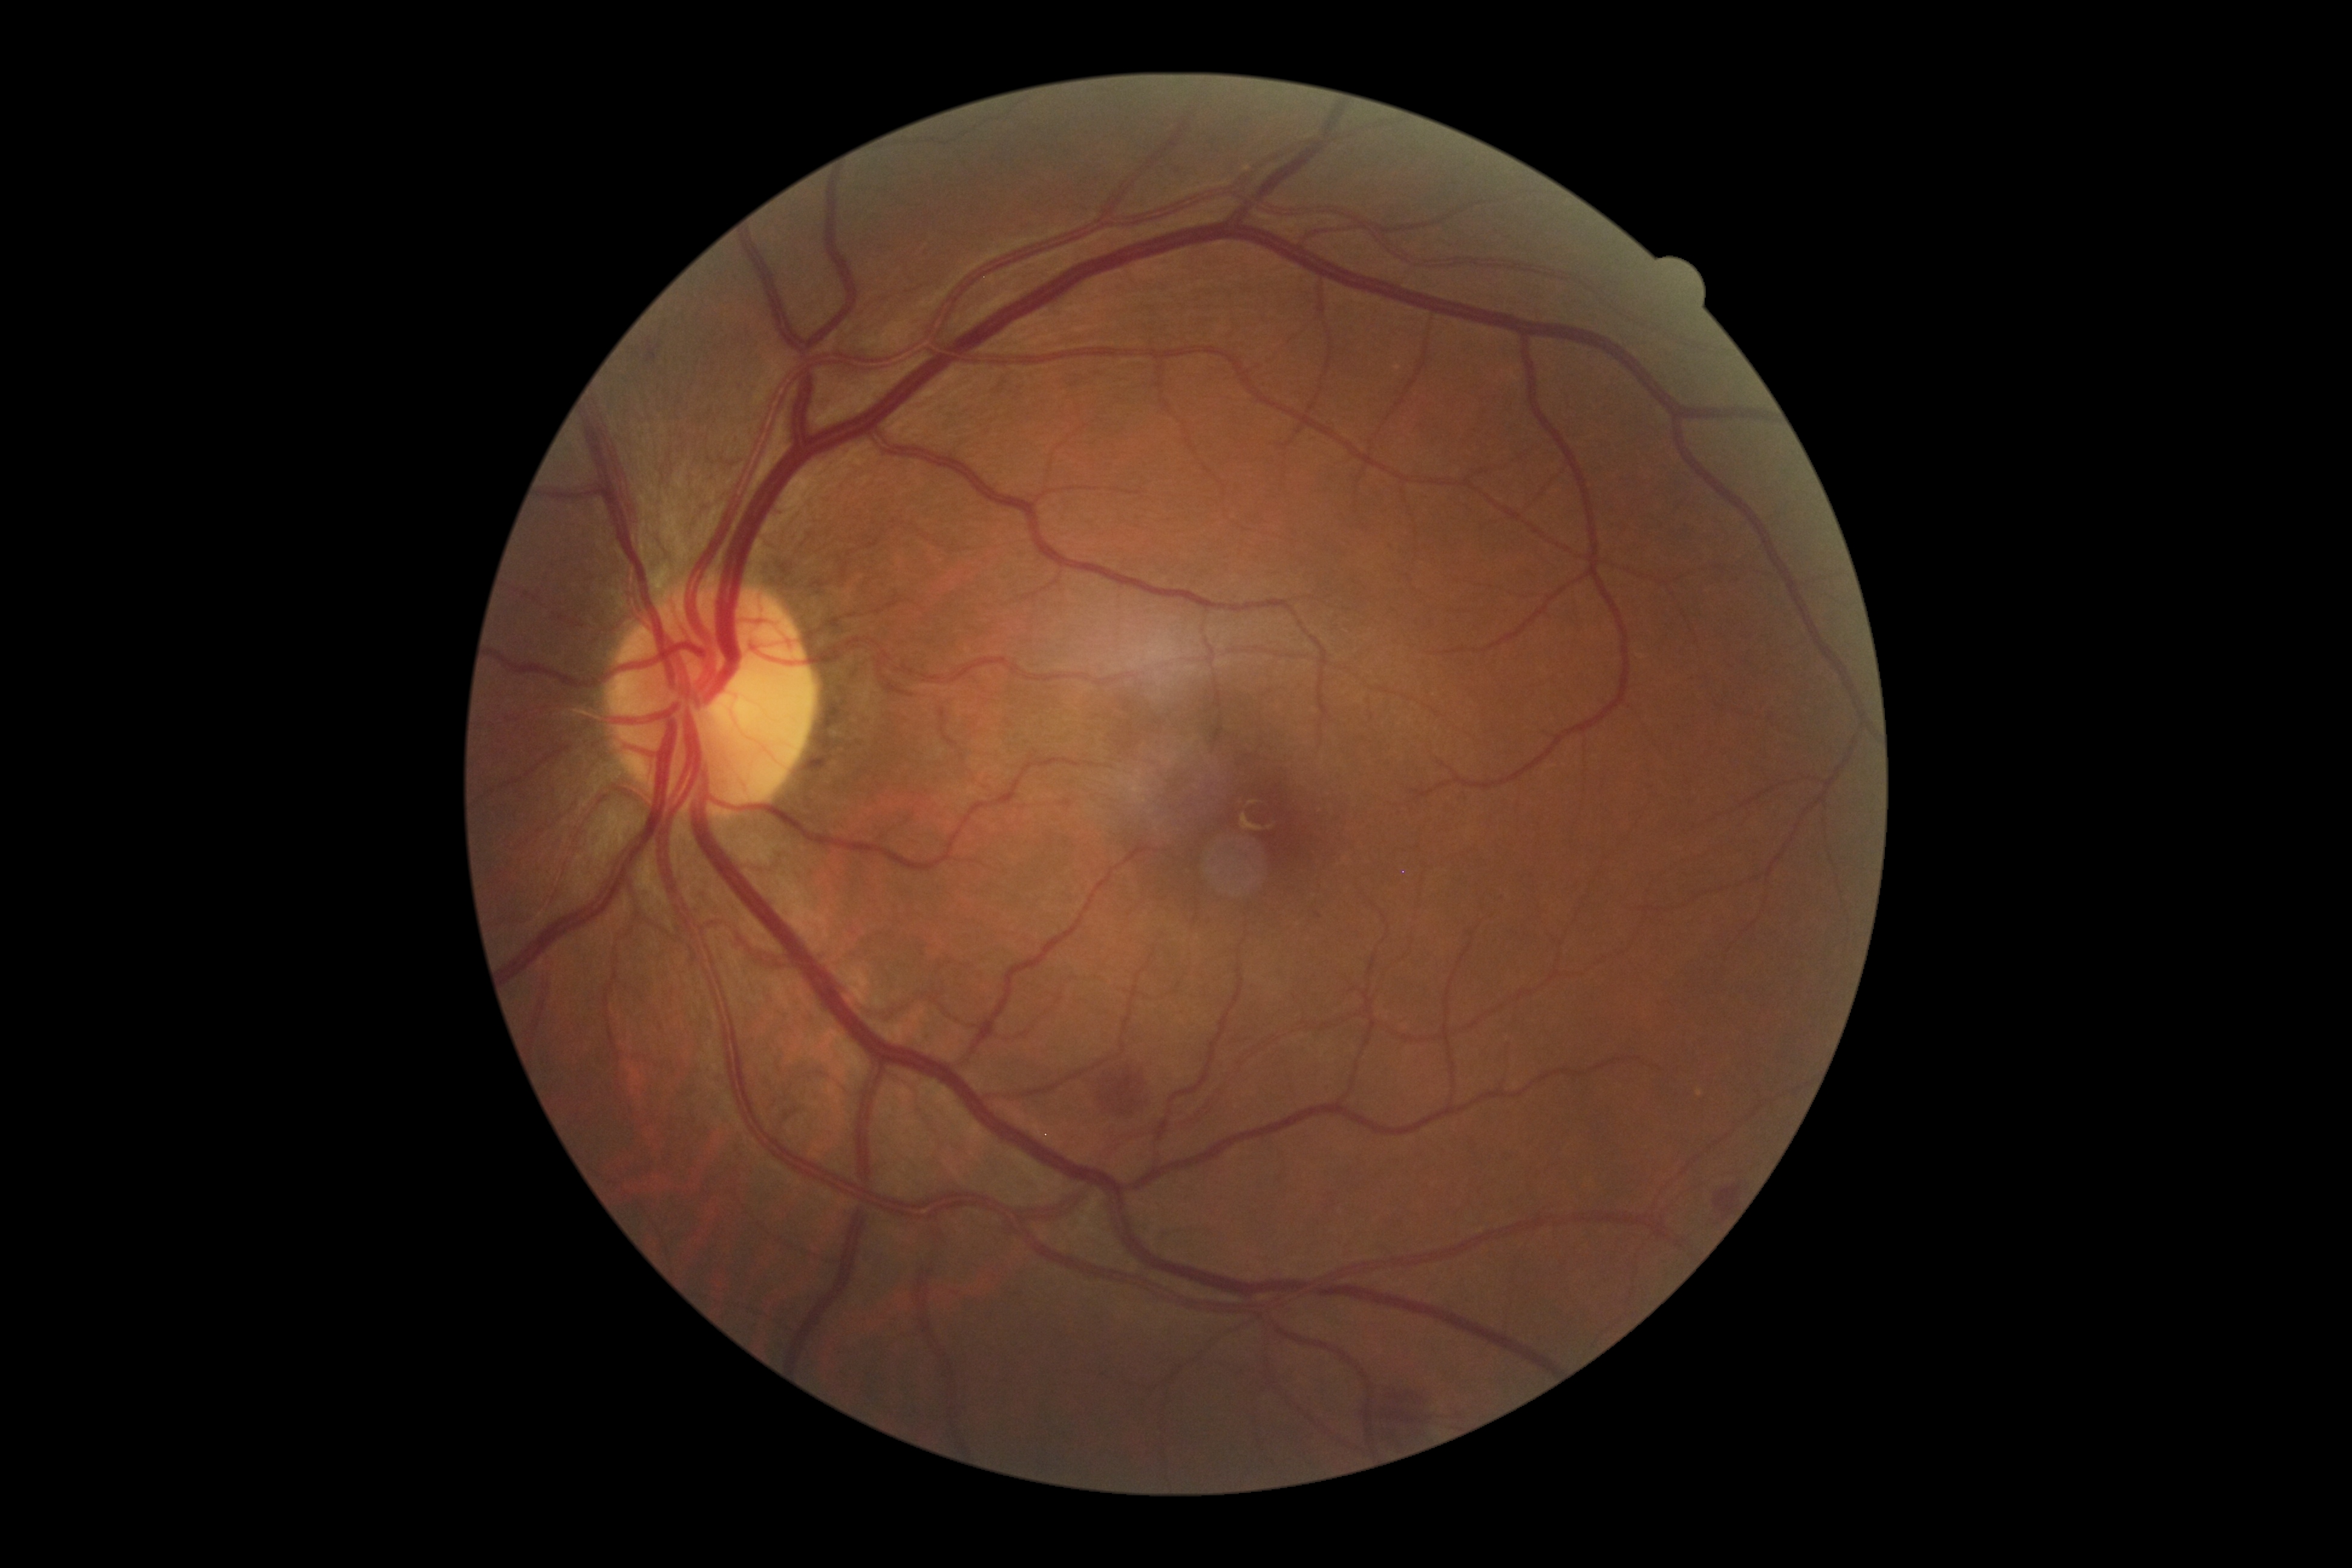
DR class: non-proliferative diabetic retinopathy.
DR grade is 2.